Modified Davis grading.
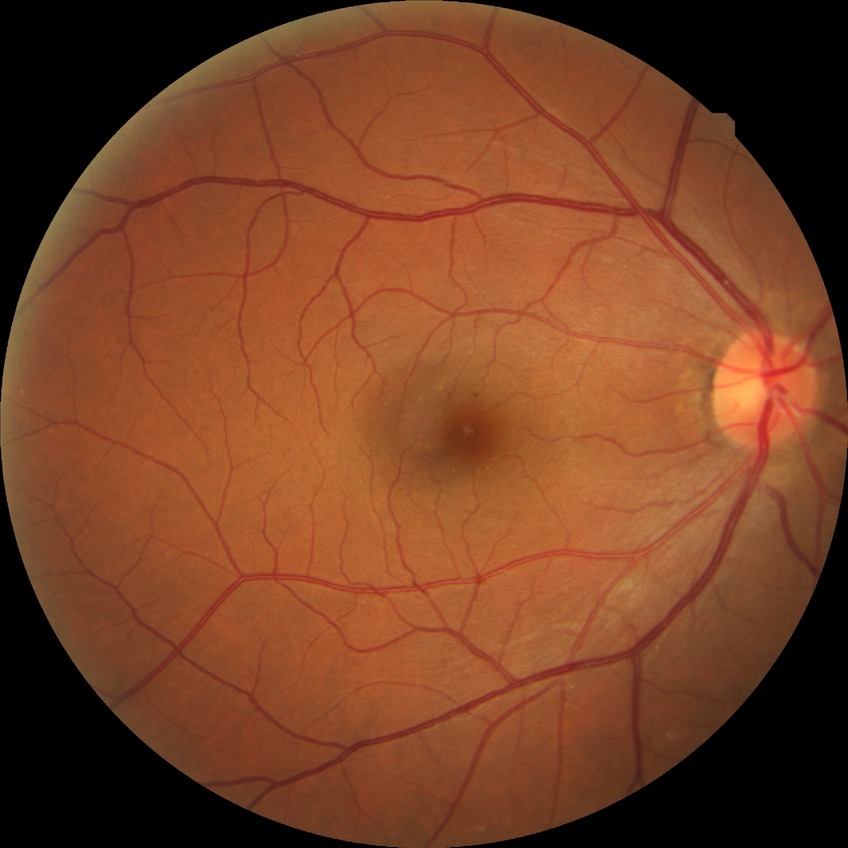

Findings:
• DR grade — SDR